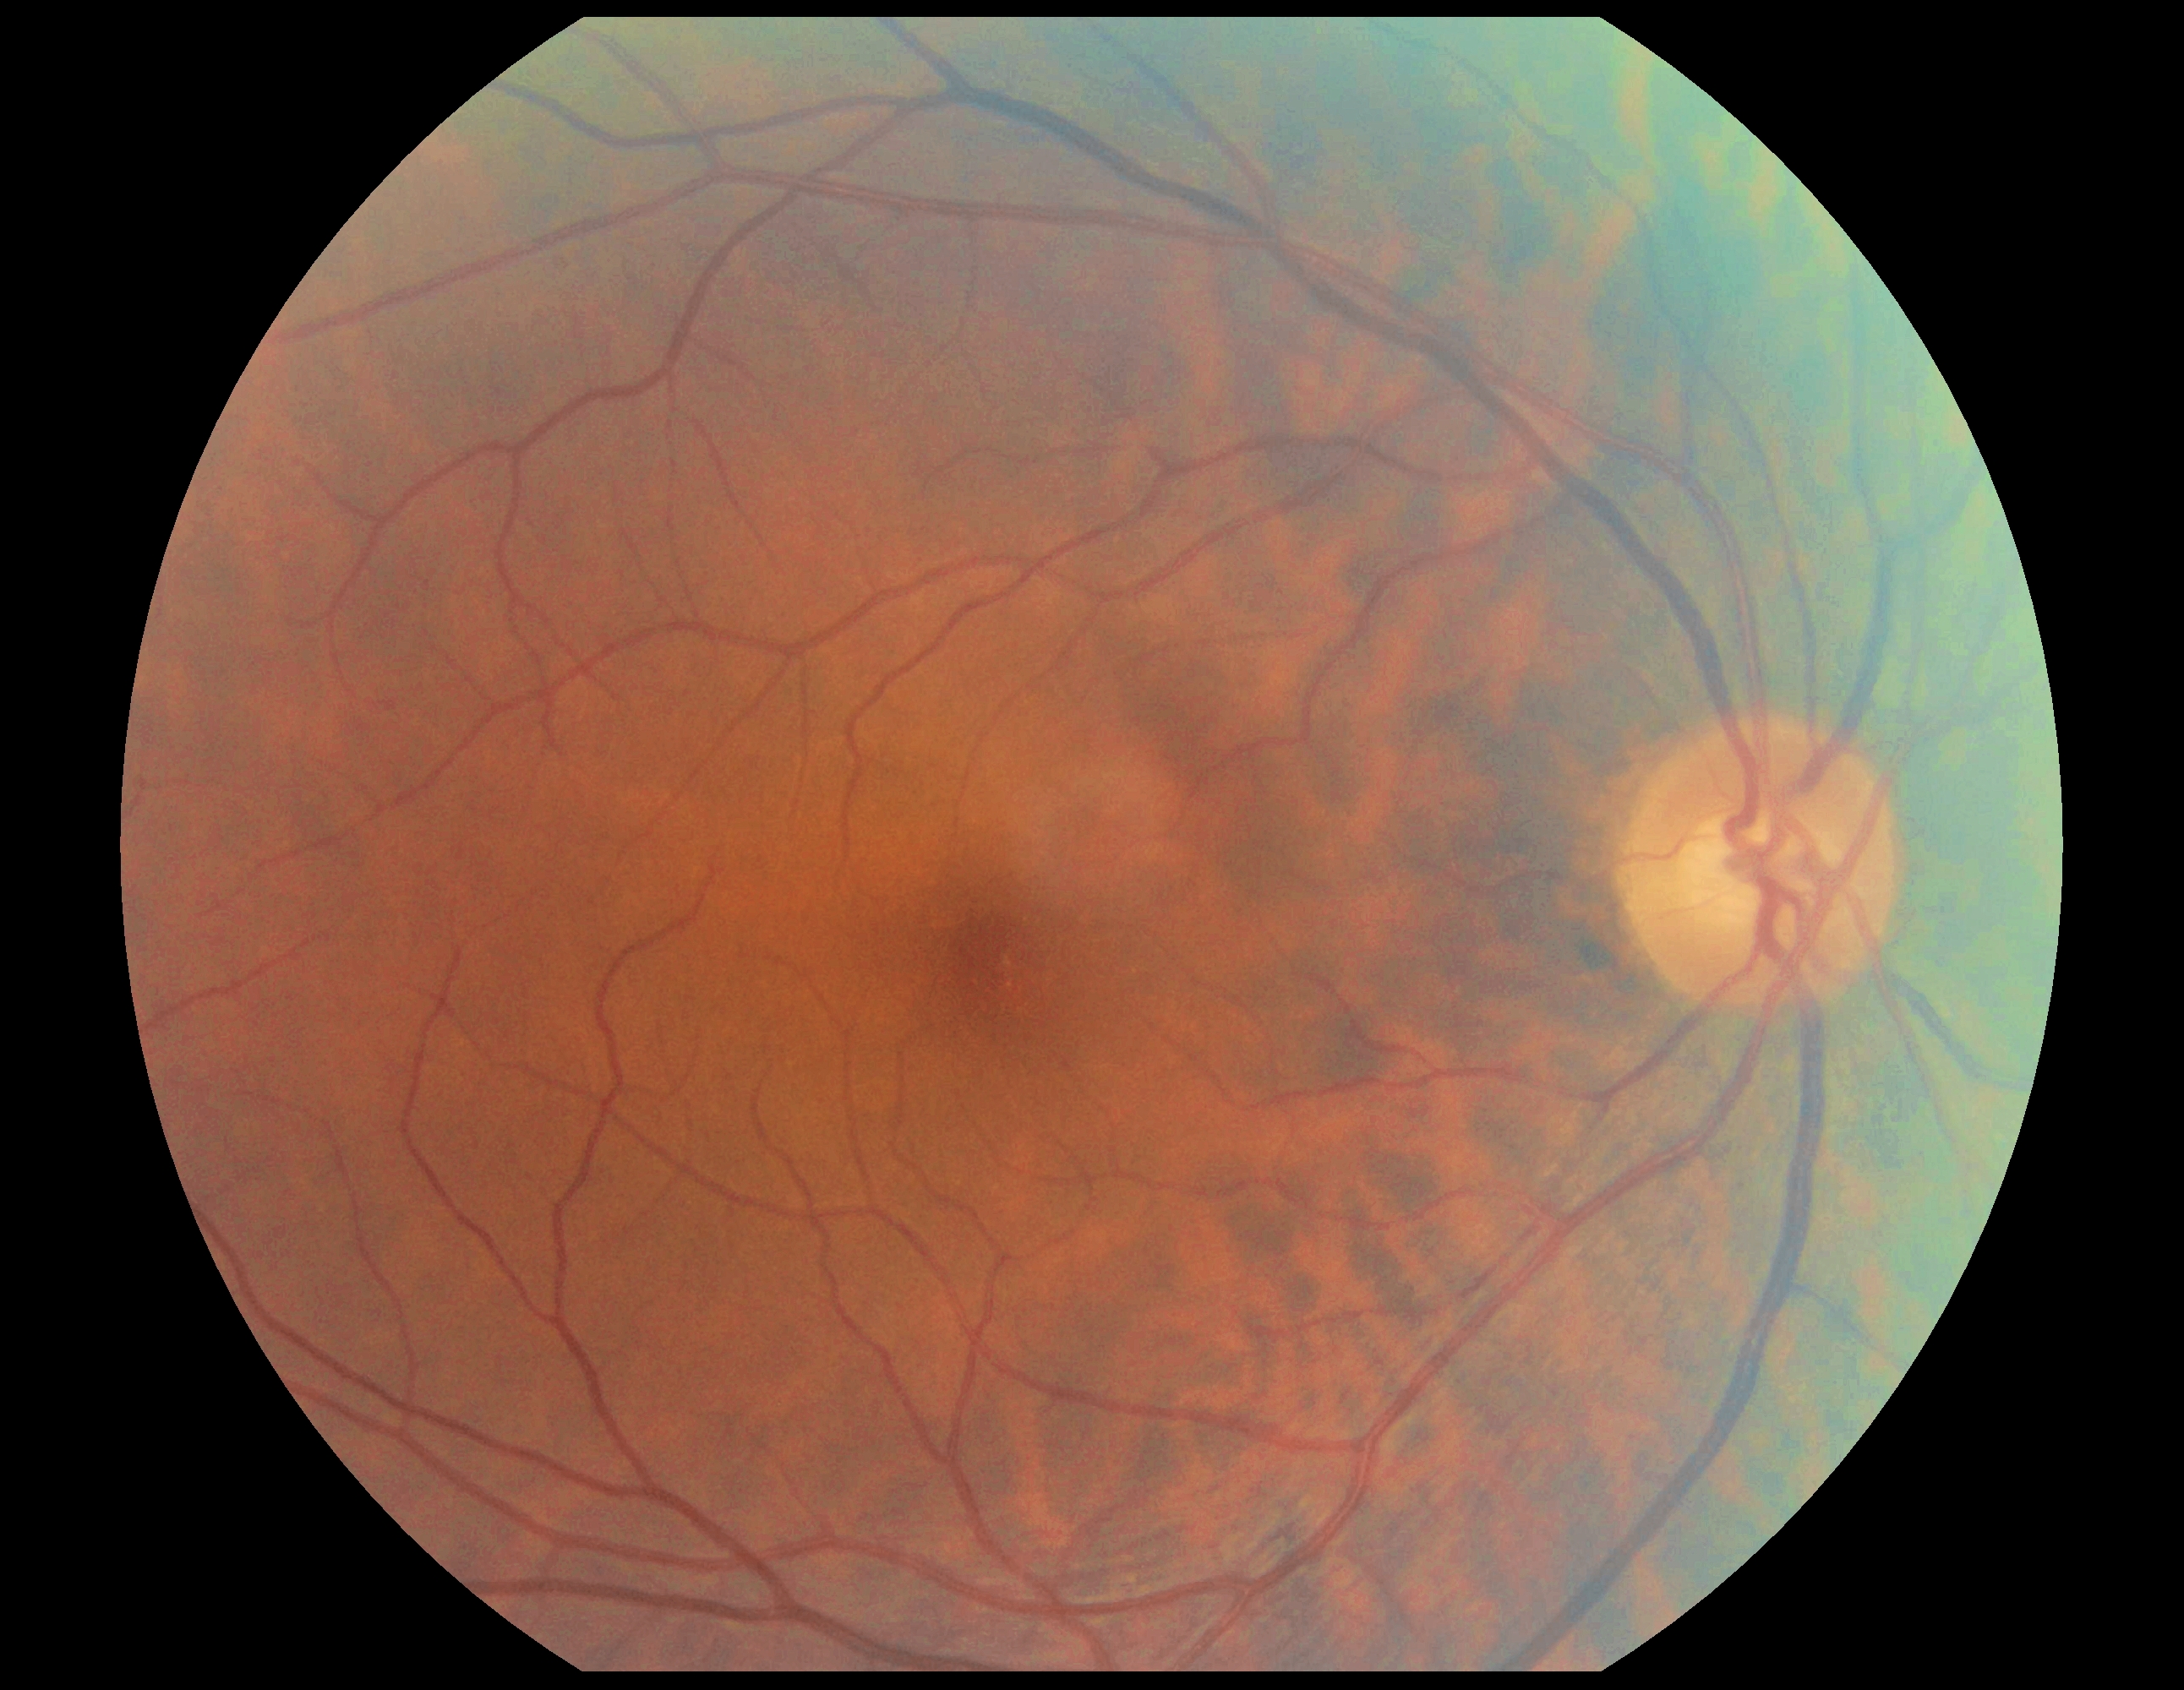

dr_grade: no apparent diabetic retinopathy (grade 0) — no visible signs of diabetic retinopathy